Nonmydriatic fundus photograph.
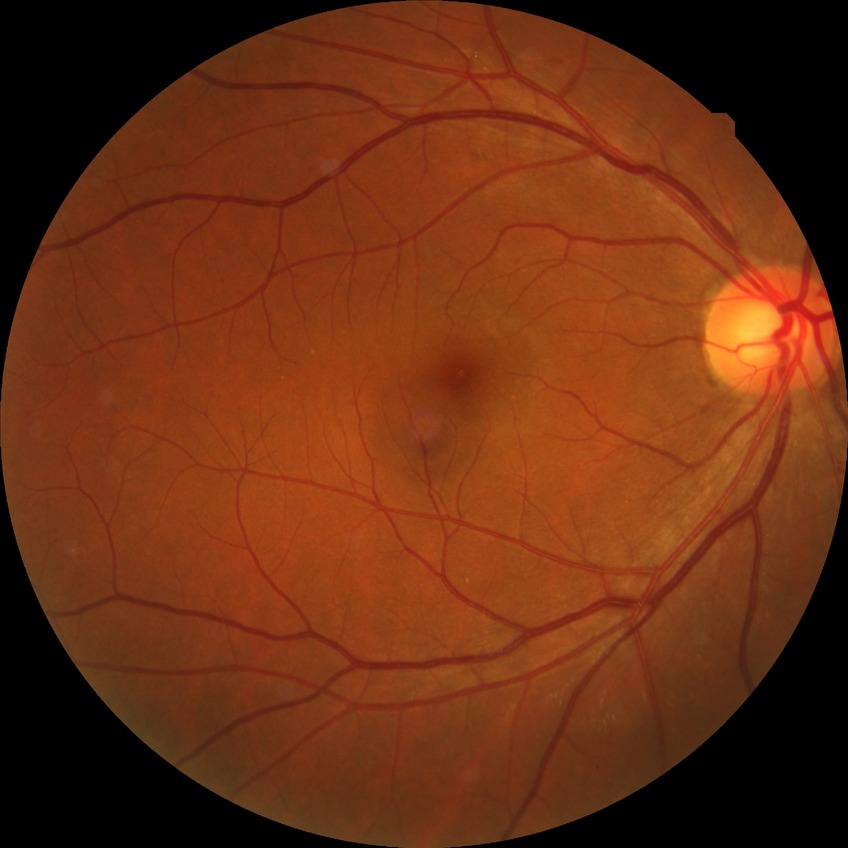 modified Davis classification@no diabetic retinopathy.